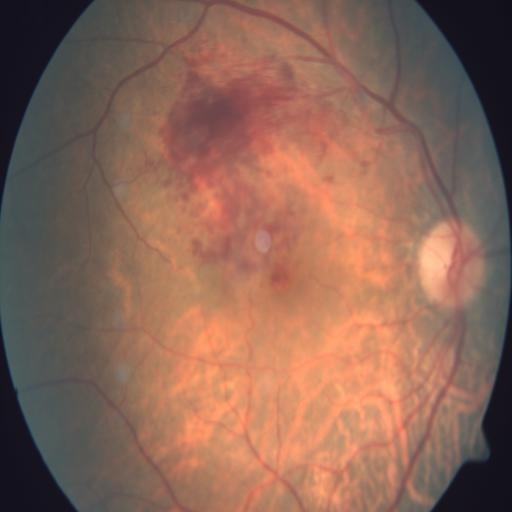 Showing branch retinal vein occlusion (BRVO).